50-degree field of view · Topcon TRC-50DX: 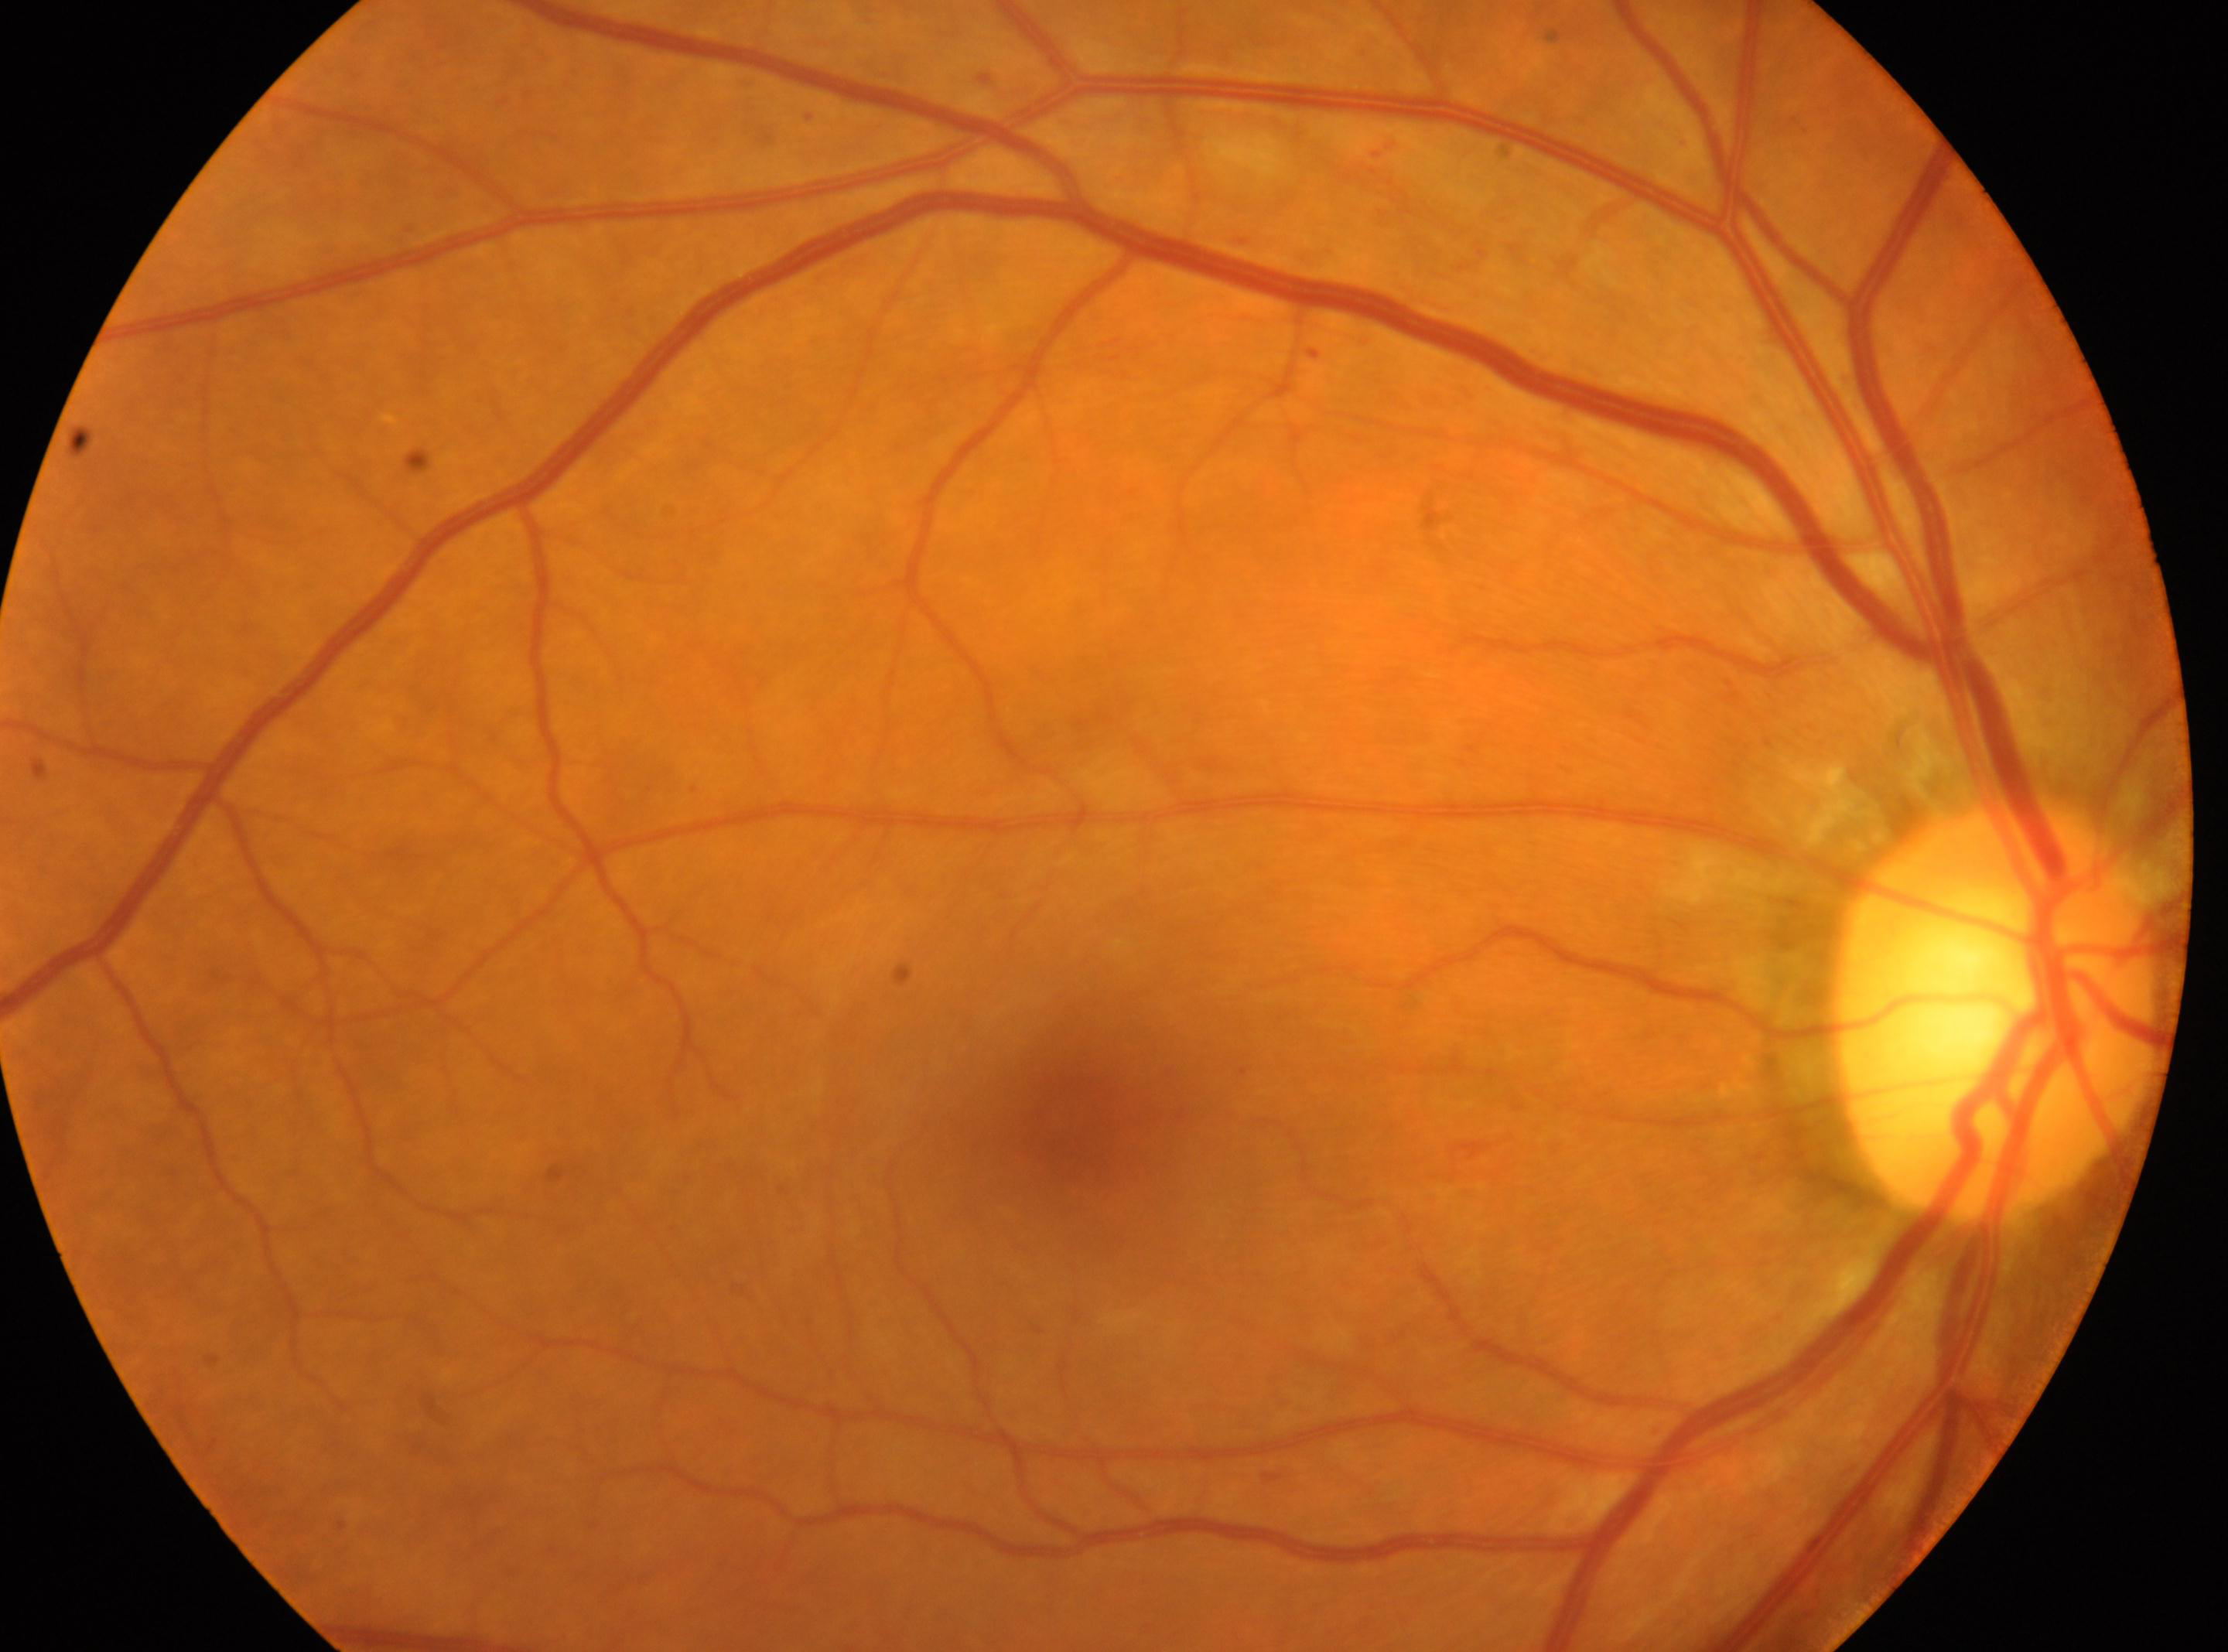 Macula center: (x=1074, y=1121).
Diabetic retinopathy grade is 1.
The optic disc is at (x=1997, y=1013).
Eye: OD.